Image size 848x848; 45-degree field of view; no pharmacologic dilation — 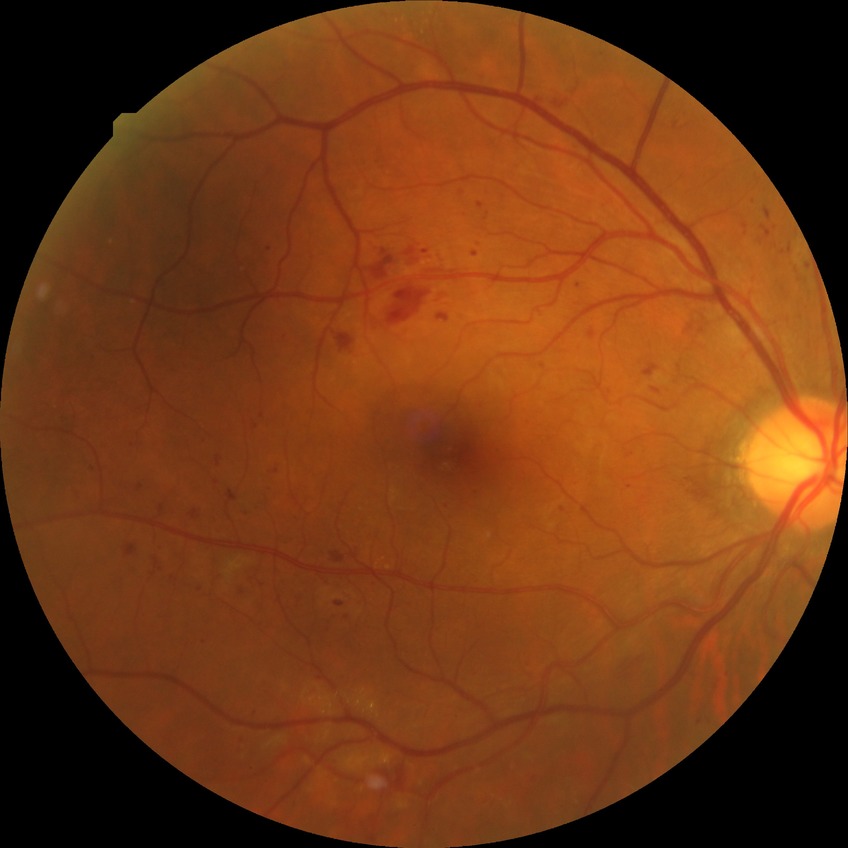 Annotations:
– diabetic retinopathy (DR) — simple diabetic retinopathy (SDR)